Phoenix ICON, 100° FOV · Phoenix ICON wide-field infant fundus image · image size 1240x1240.
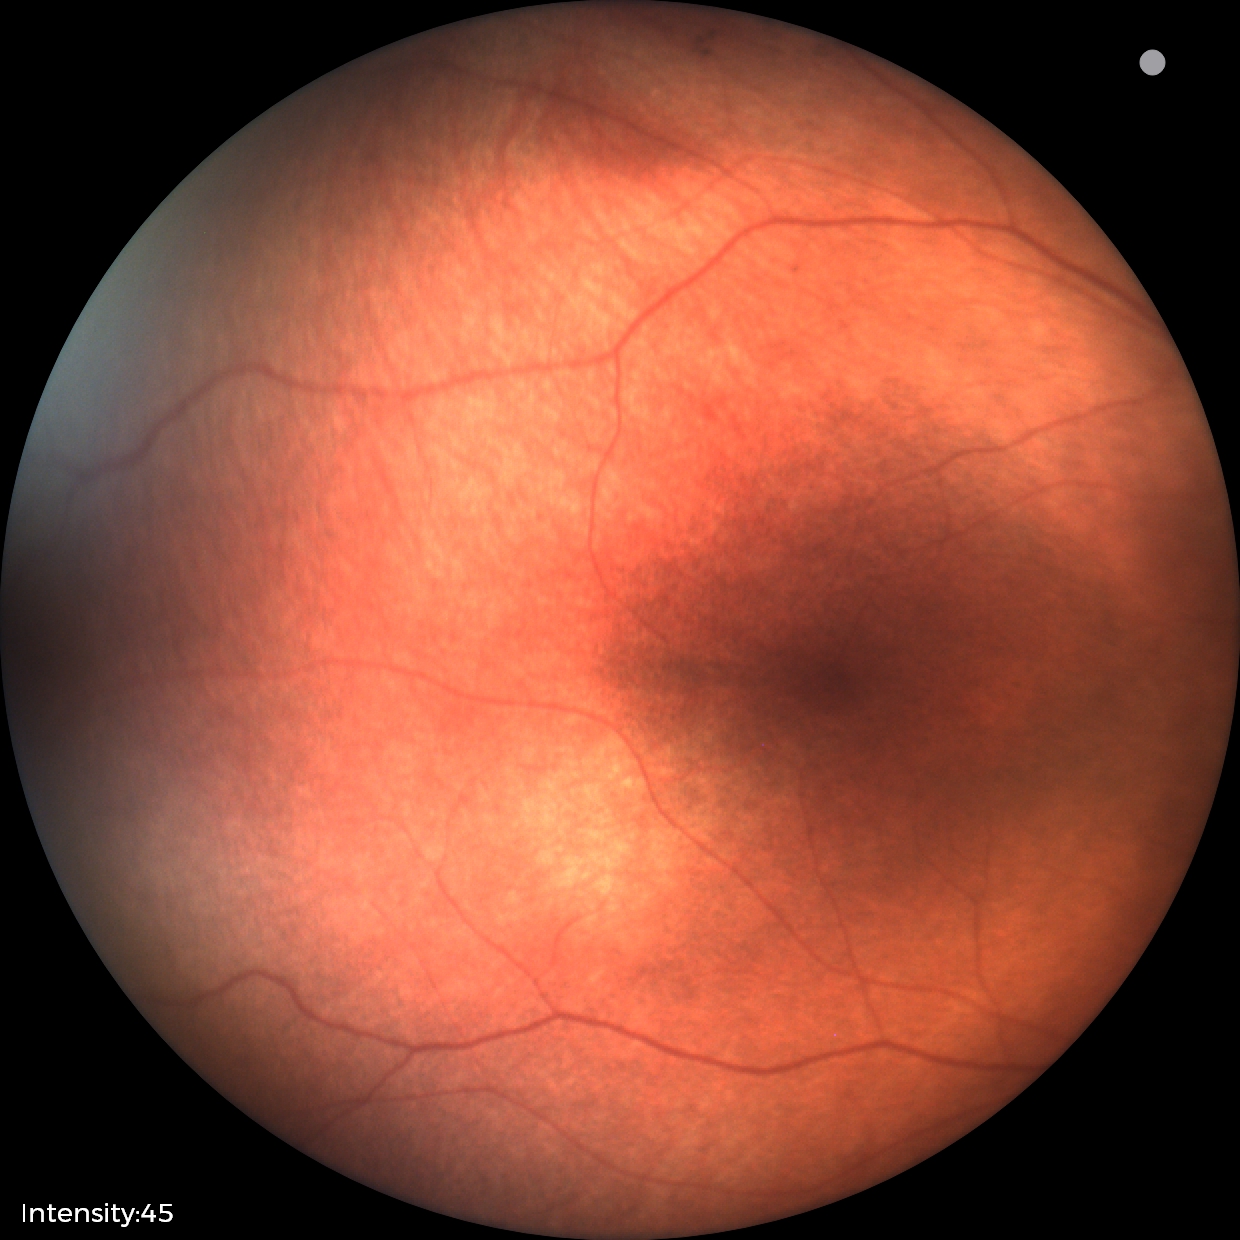

Physiological retinal appearance for postconceptual age.